45° field of view; retinal fundus photograph
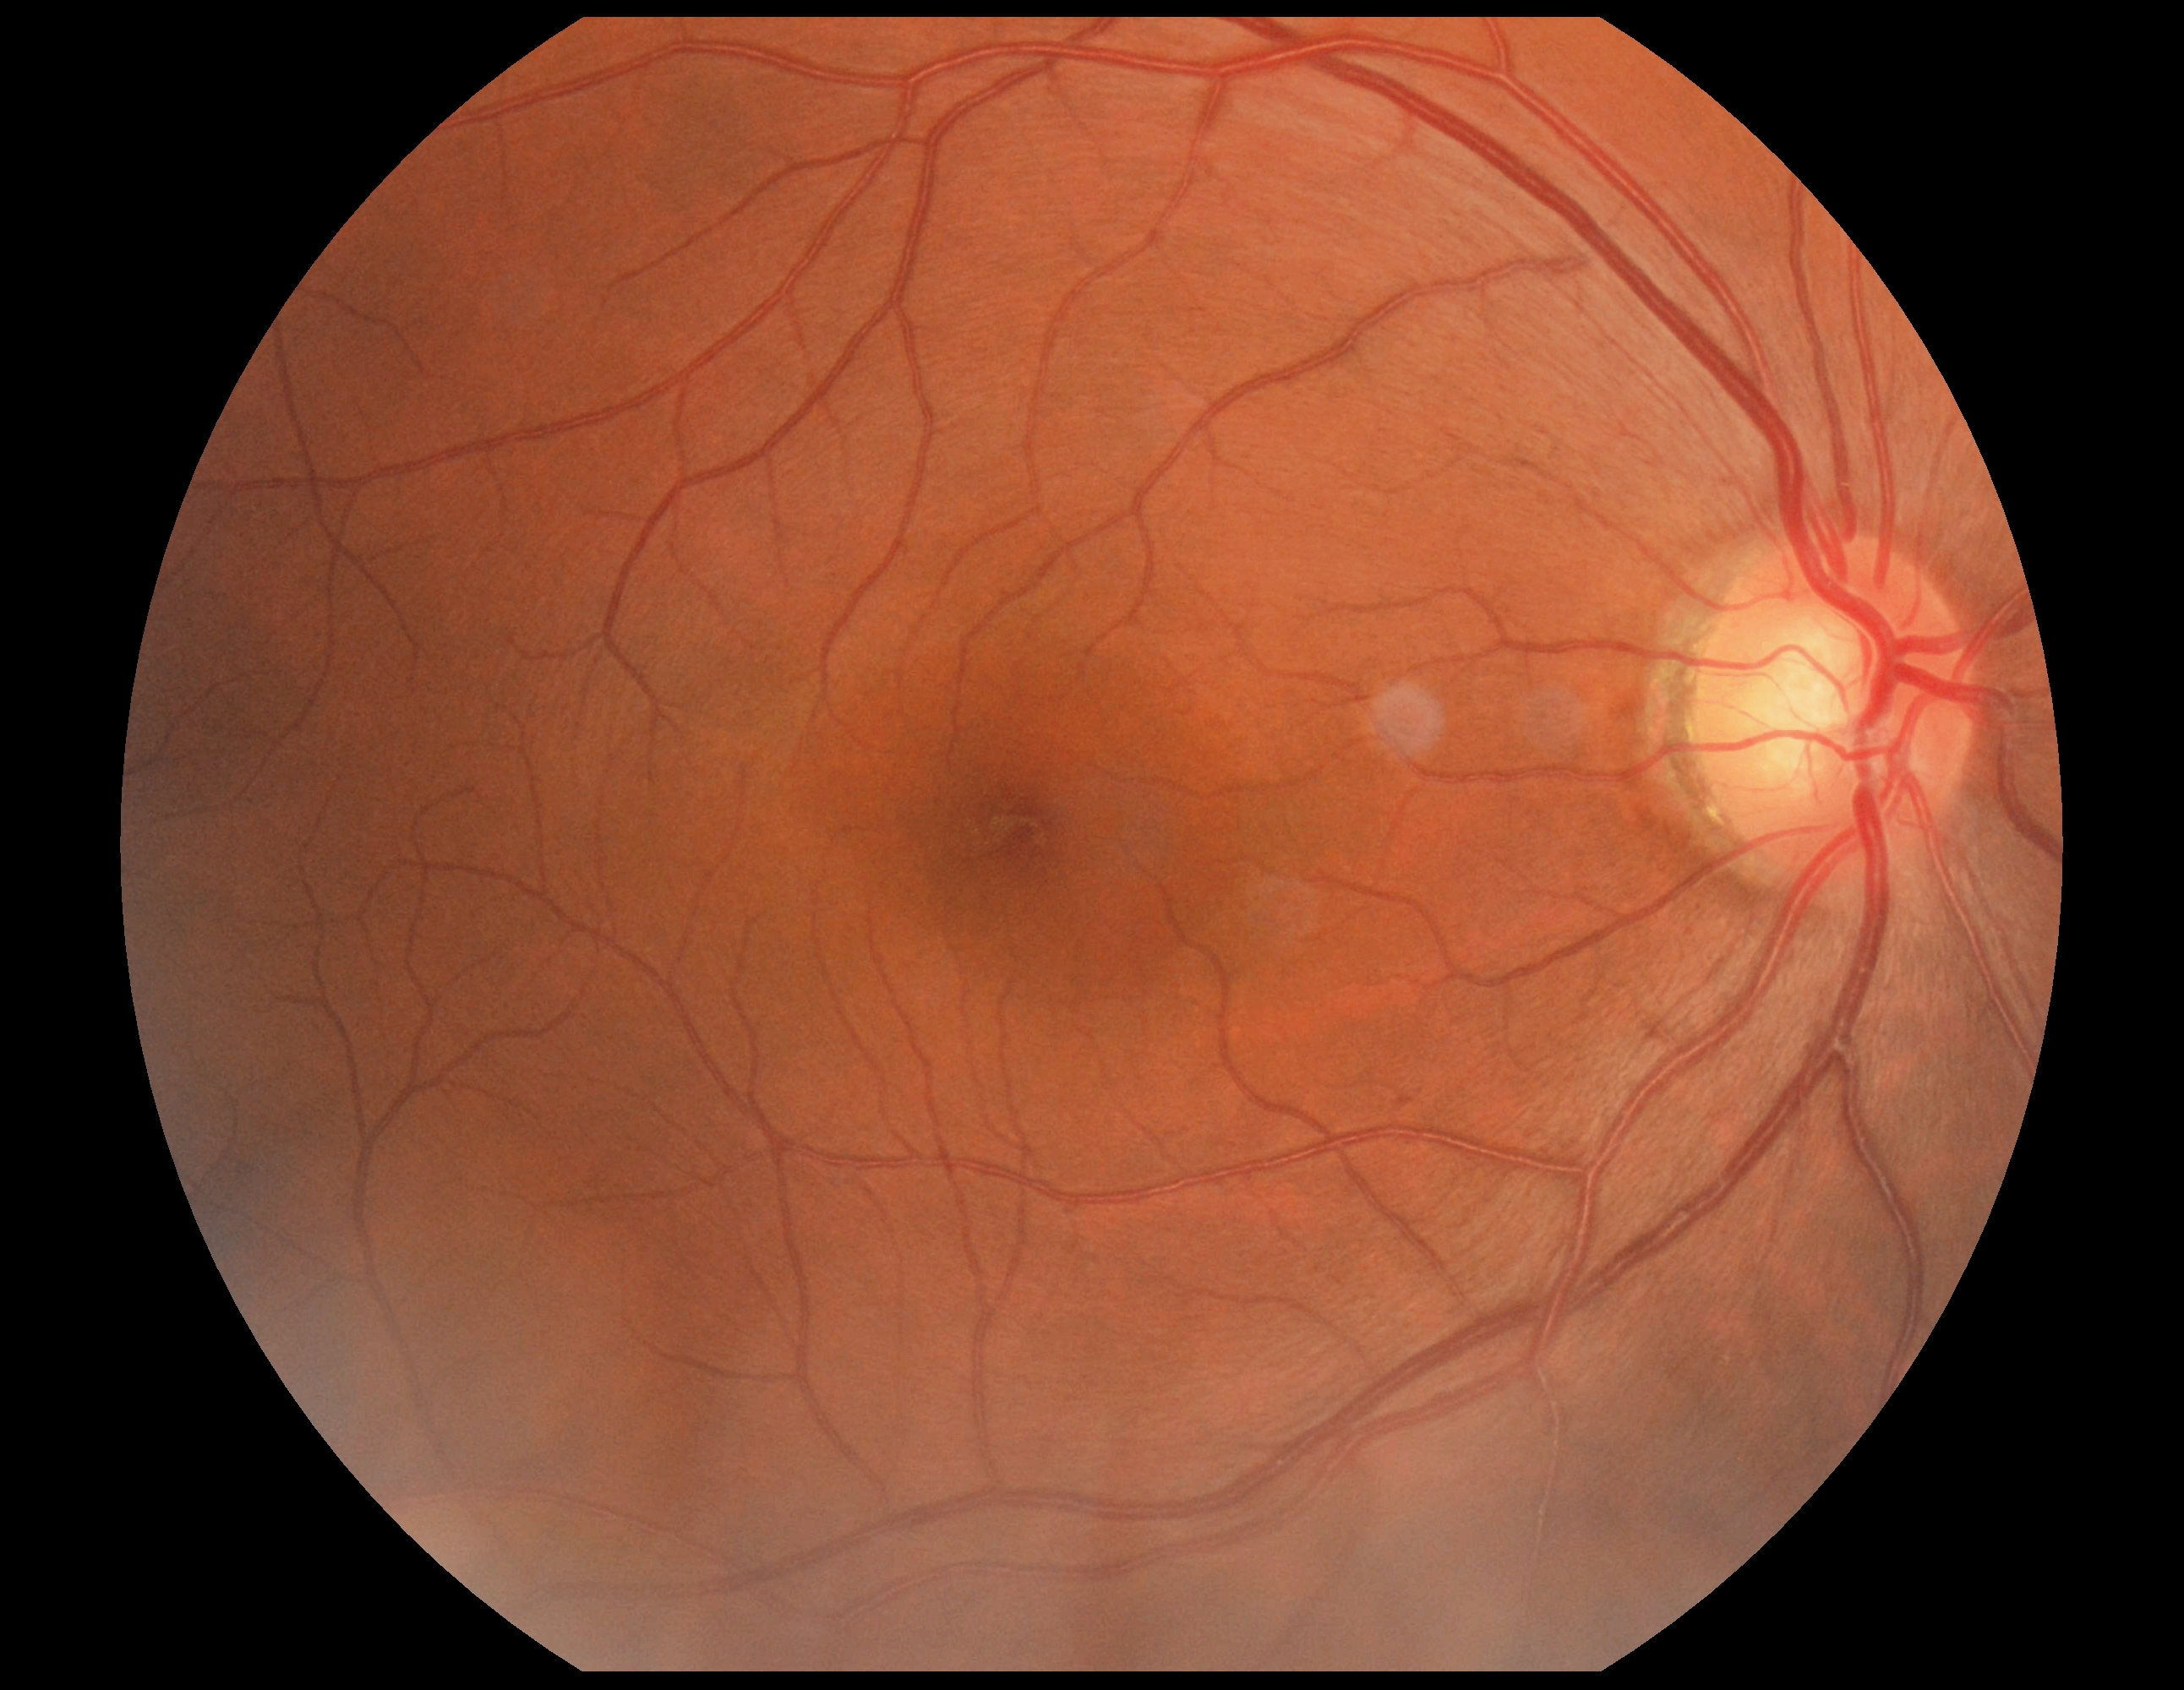
Diabetic retinopathy is no apparent diabetic retinopathy (grade 0).